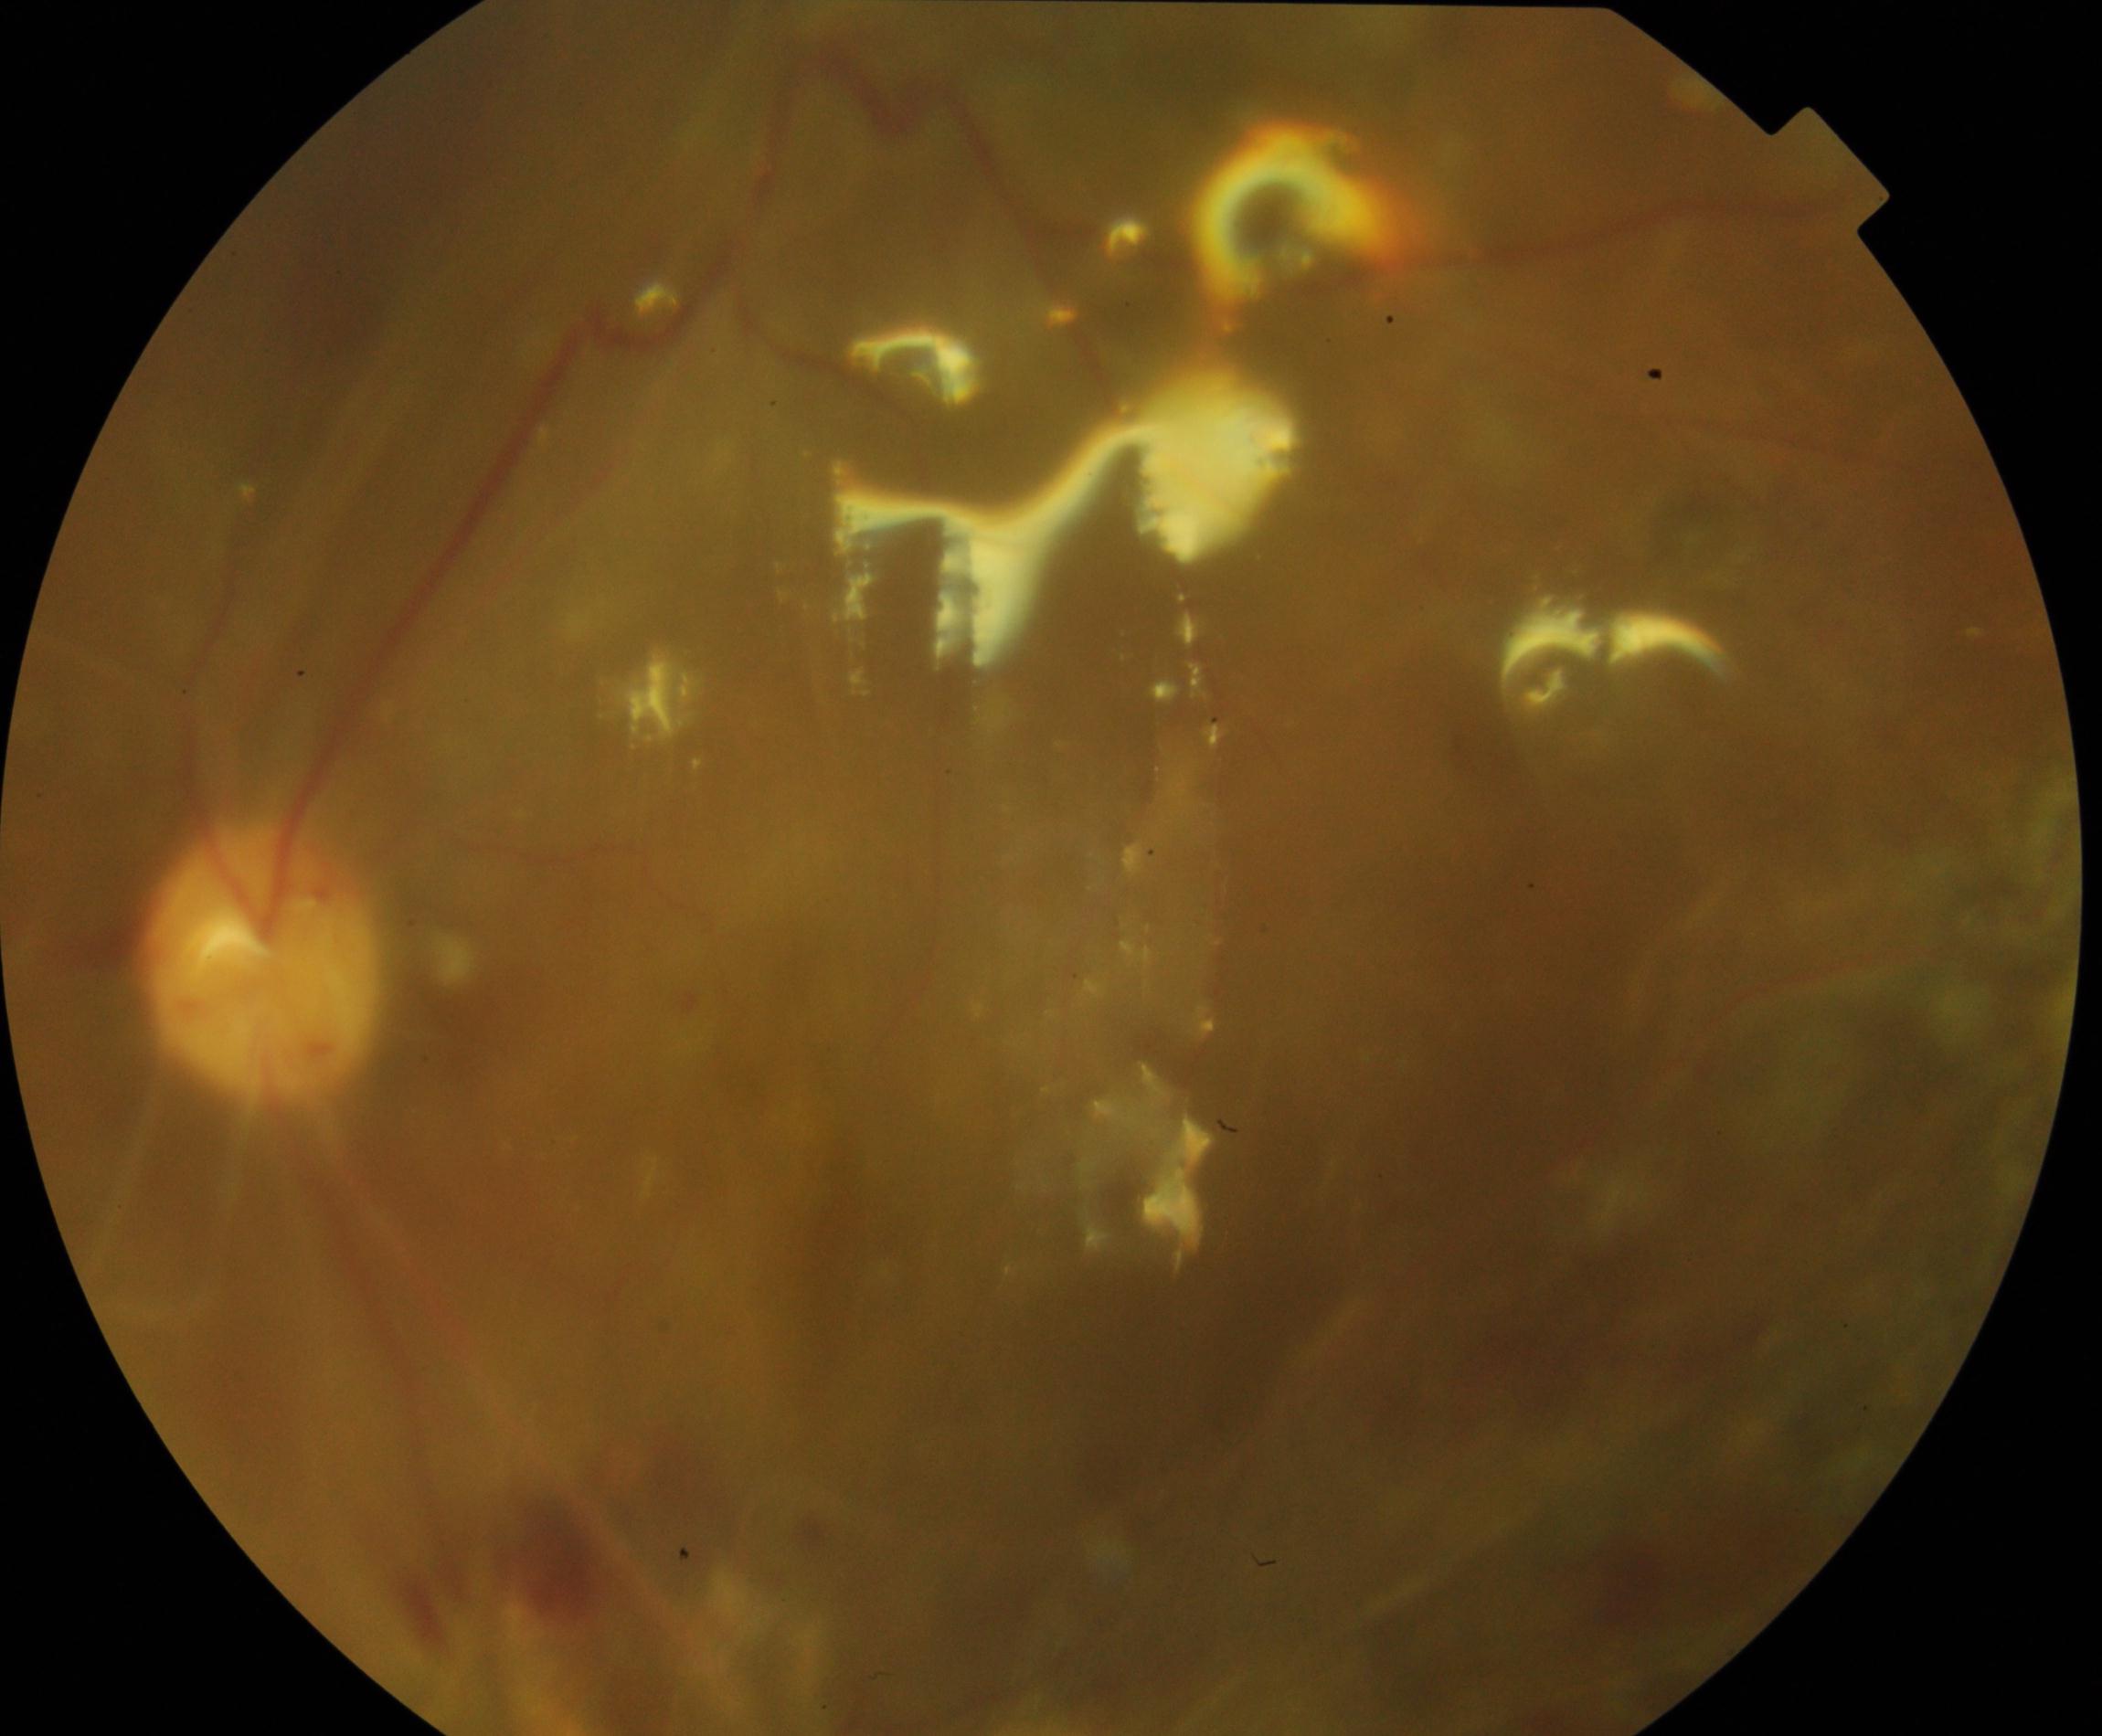

Notable finding: silicone oil in the eye.